FOV: 50 degrees · camera: Topcon TRC-50DX · pupil-dilated — 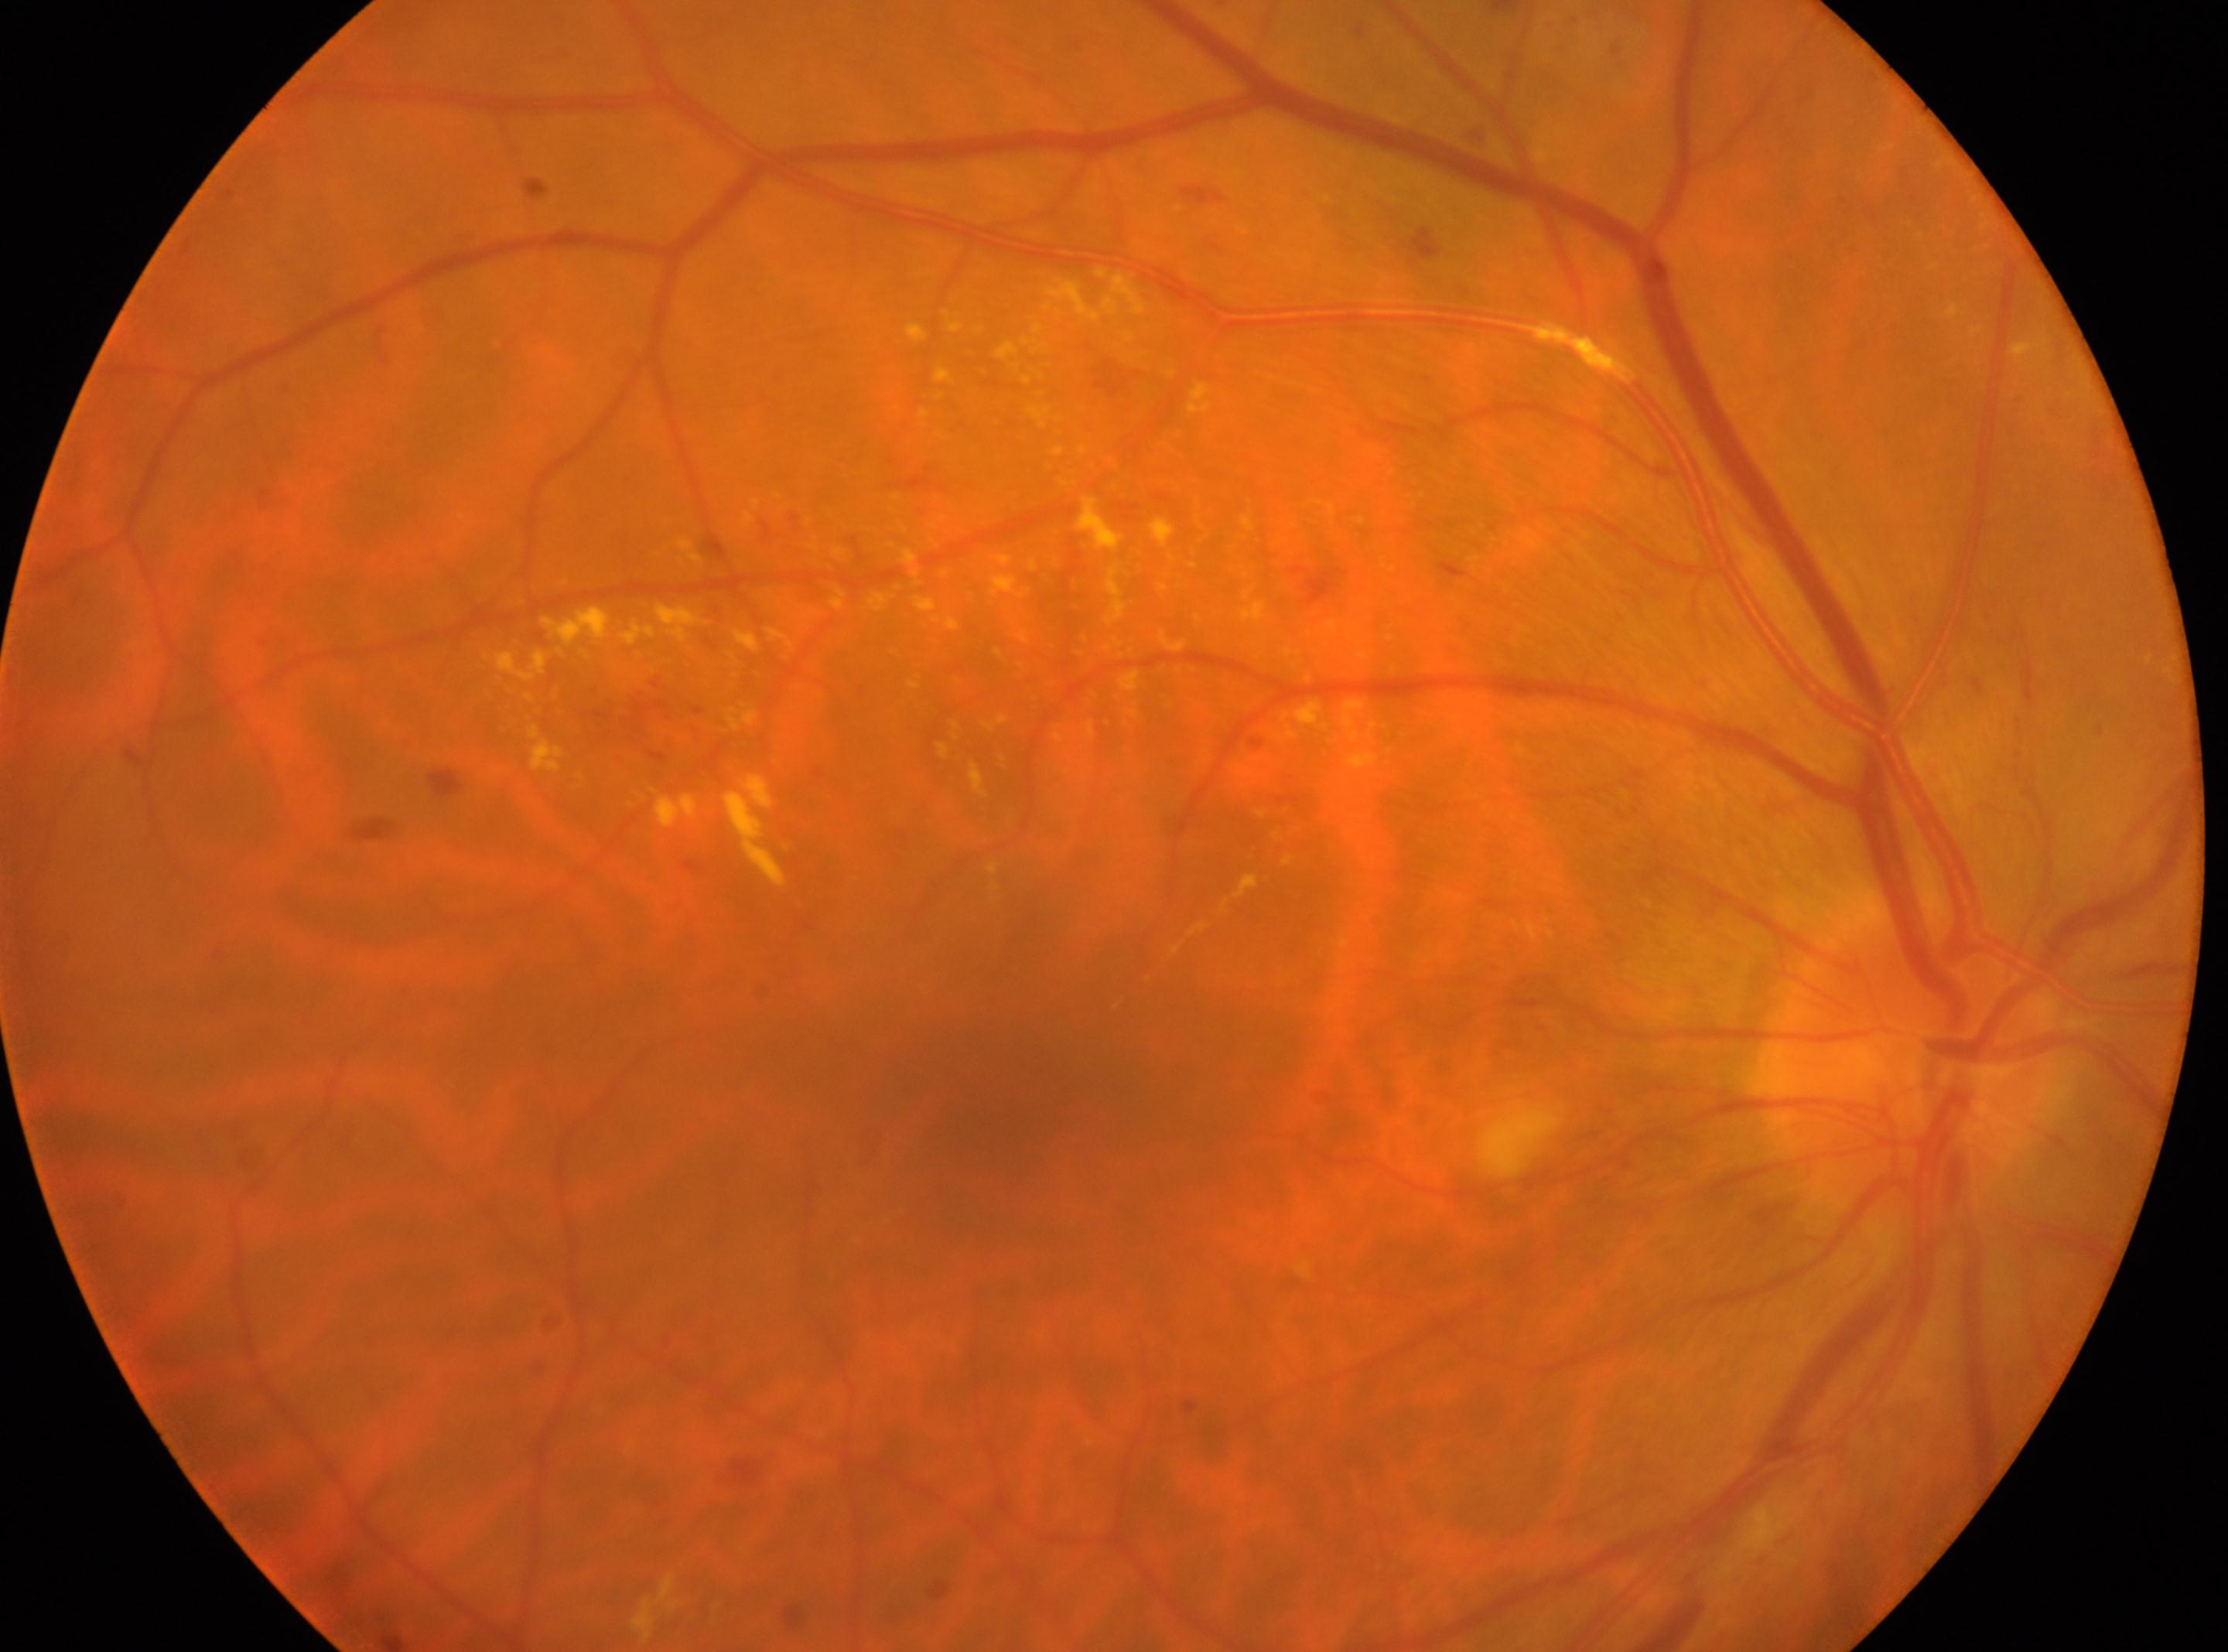
right eye; ONH: (1905, 1060); fovea: (1023, 1080); DR: moderate NPDR (grade 2).